Graded on the modified Davis scale:
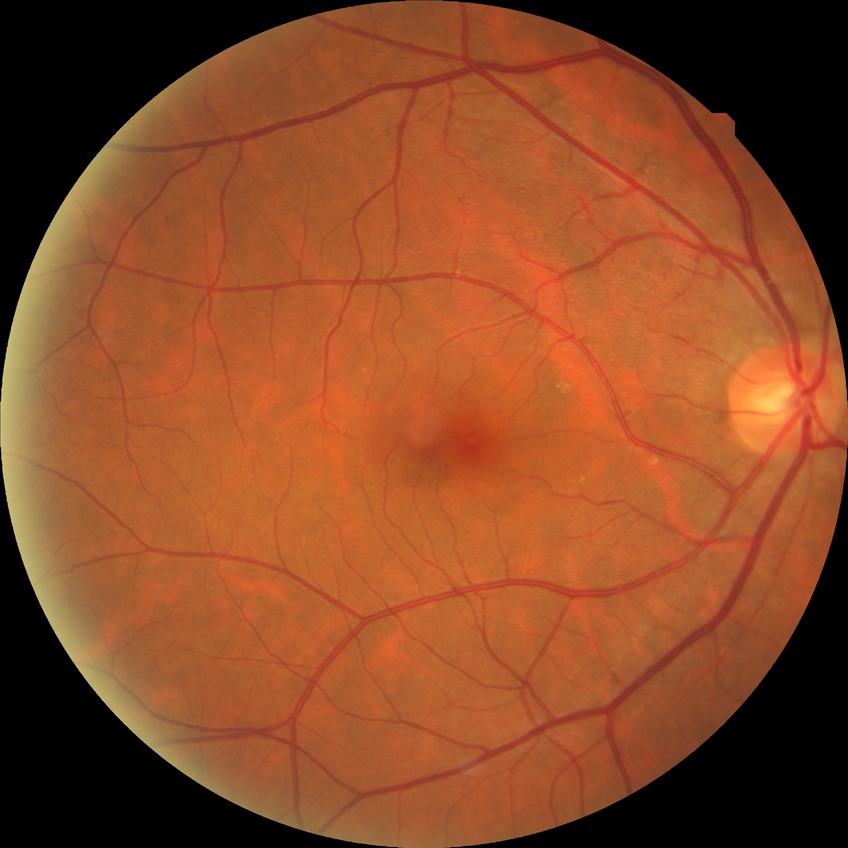 Diabetic retinopathy (DR): NDR (no diabetic retinopathy).